848x848, 45-degree field of view, NIDEK AFC-230, CFP, nonmydriatic fundus photograph:
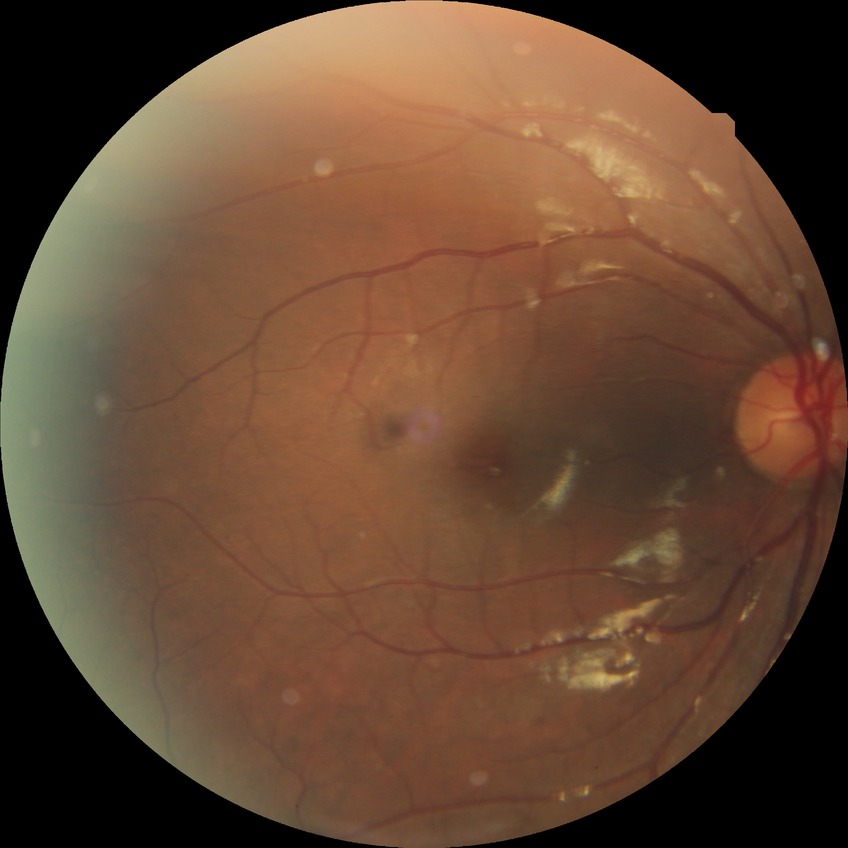
No signs of diabetic retinopathy.
Modified Davis grade is NDR.